1240x1240px. Pediatric wide-field fundus photograph: 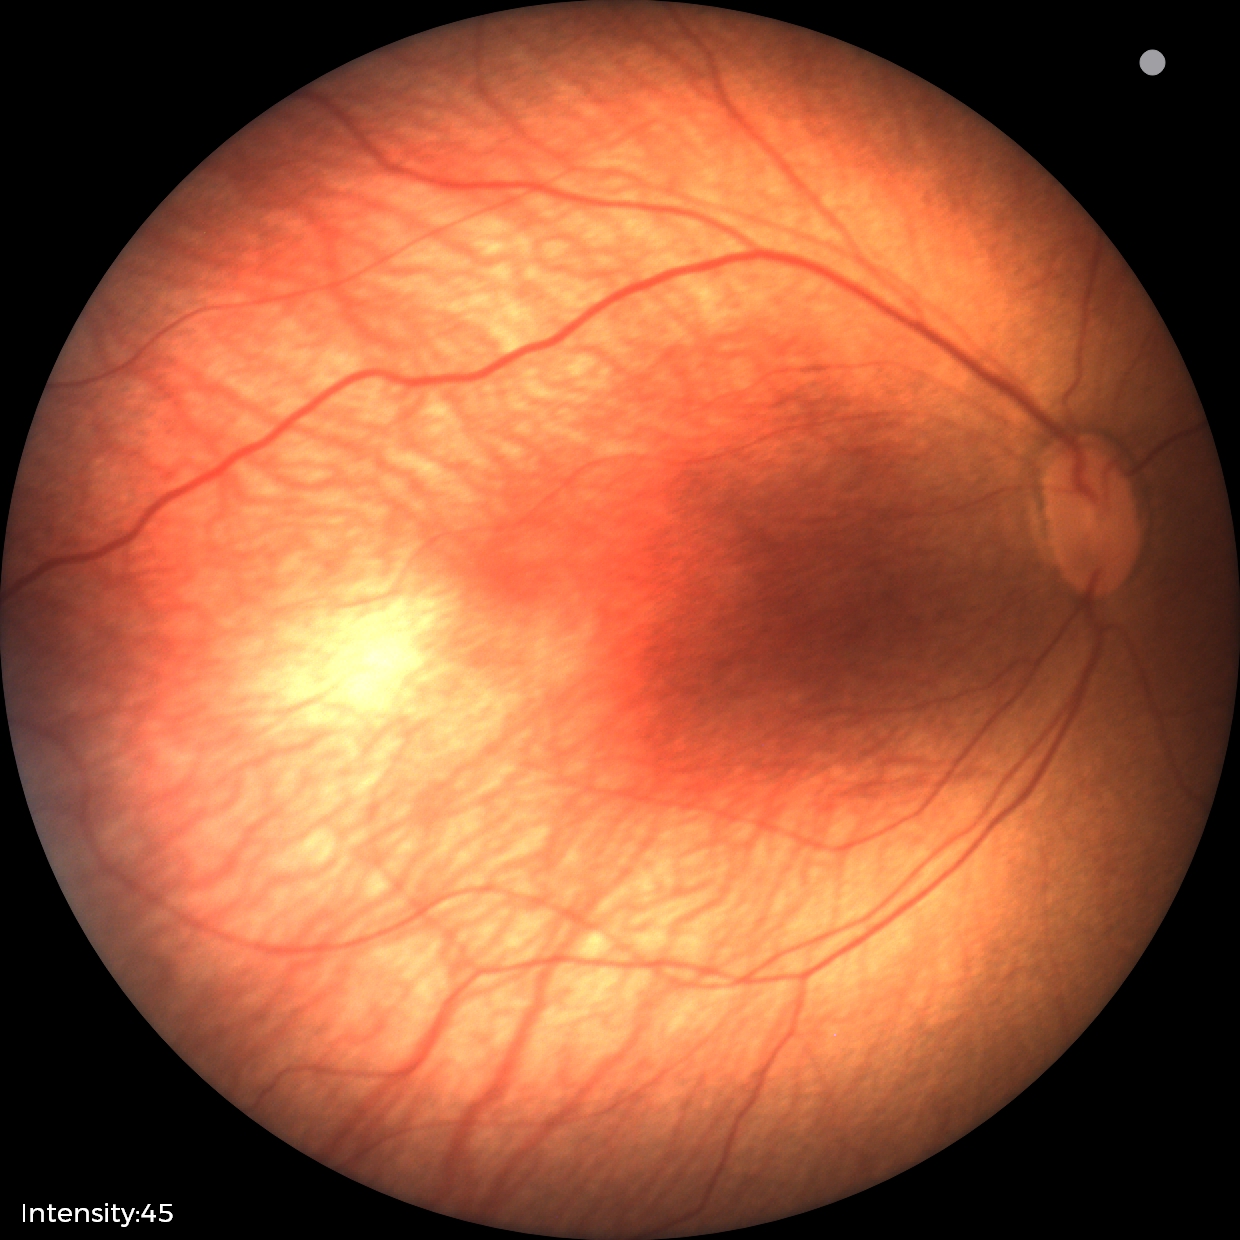
Retinopathy of prematurity stage: 1 | plus disease: absent.